RetCam wide-field infant fundus image.
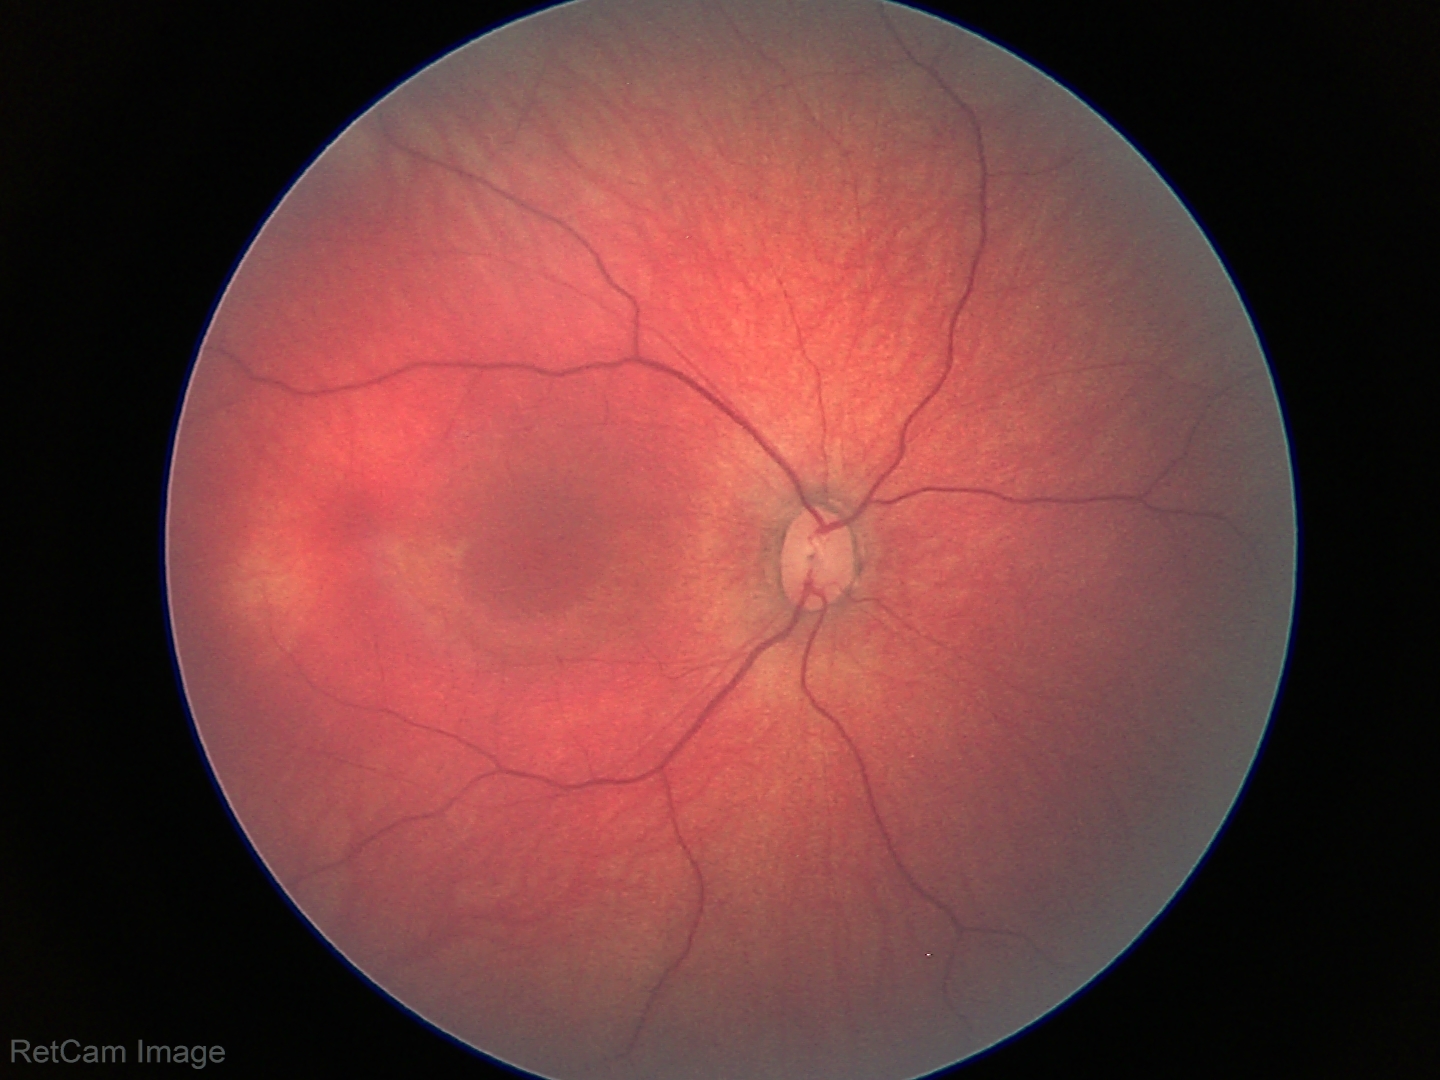 Normal screening examination.